45° field of view:
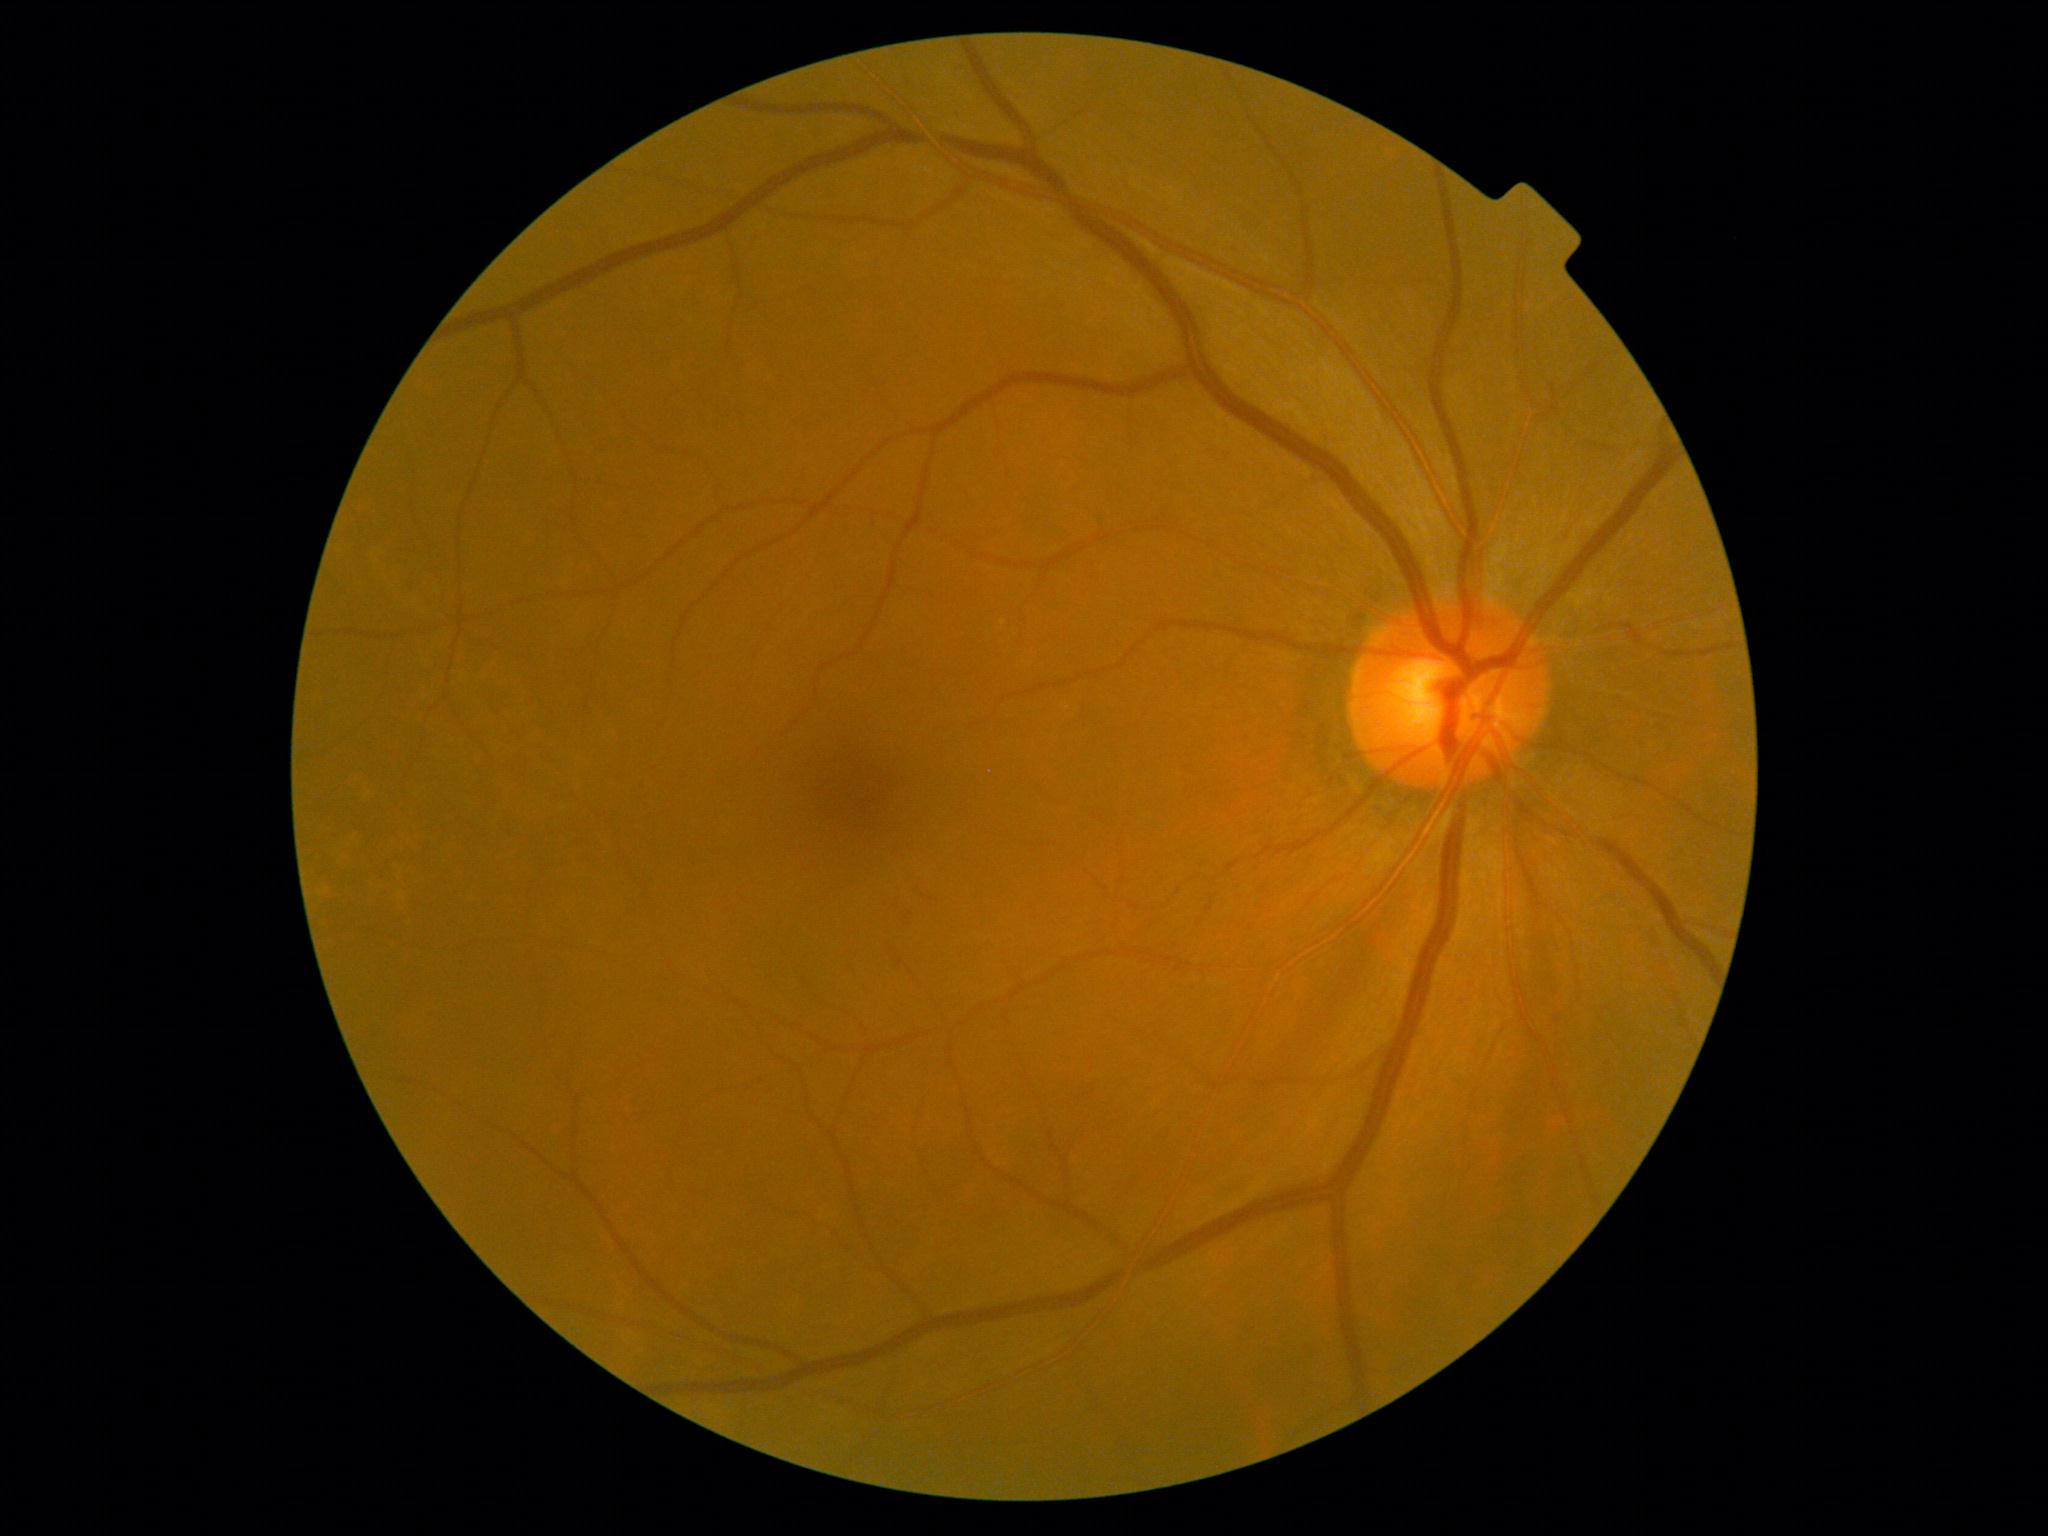

Findings:
* DR severity: no apparent retinopathy (grade 0)
* DR impression: no signs of DR